Graded on the modified Davis scale — 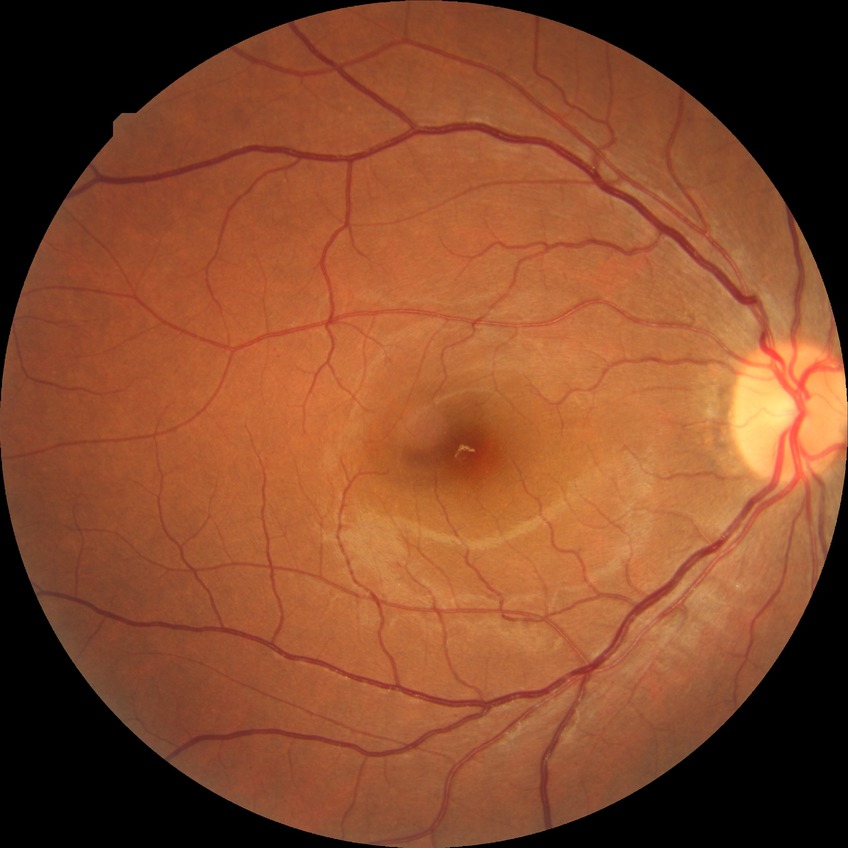 modified Davis grade: SDR.